Image size 2352x1568, 45° field of view, color fundus photograph:
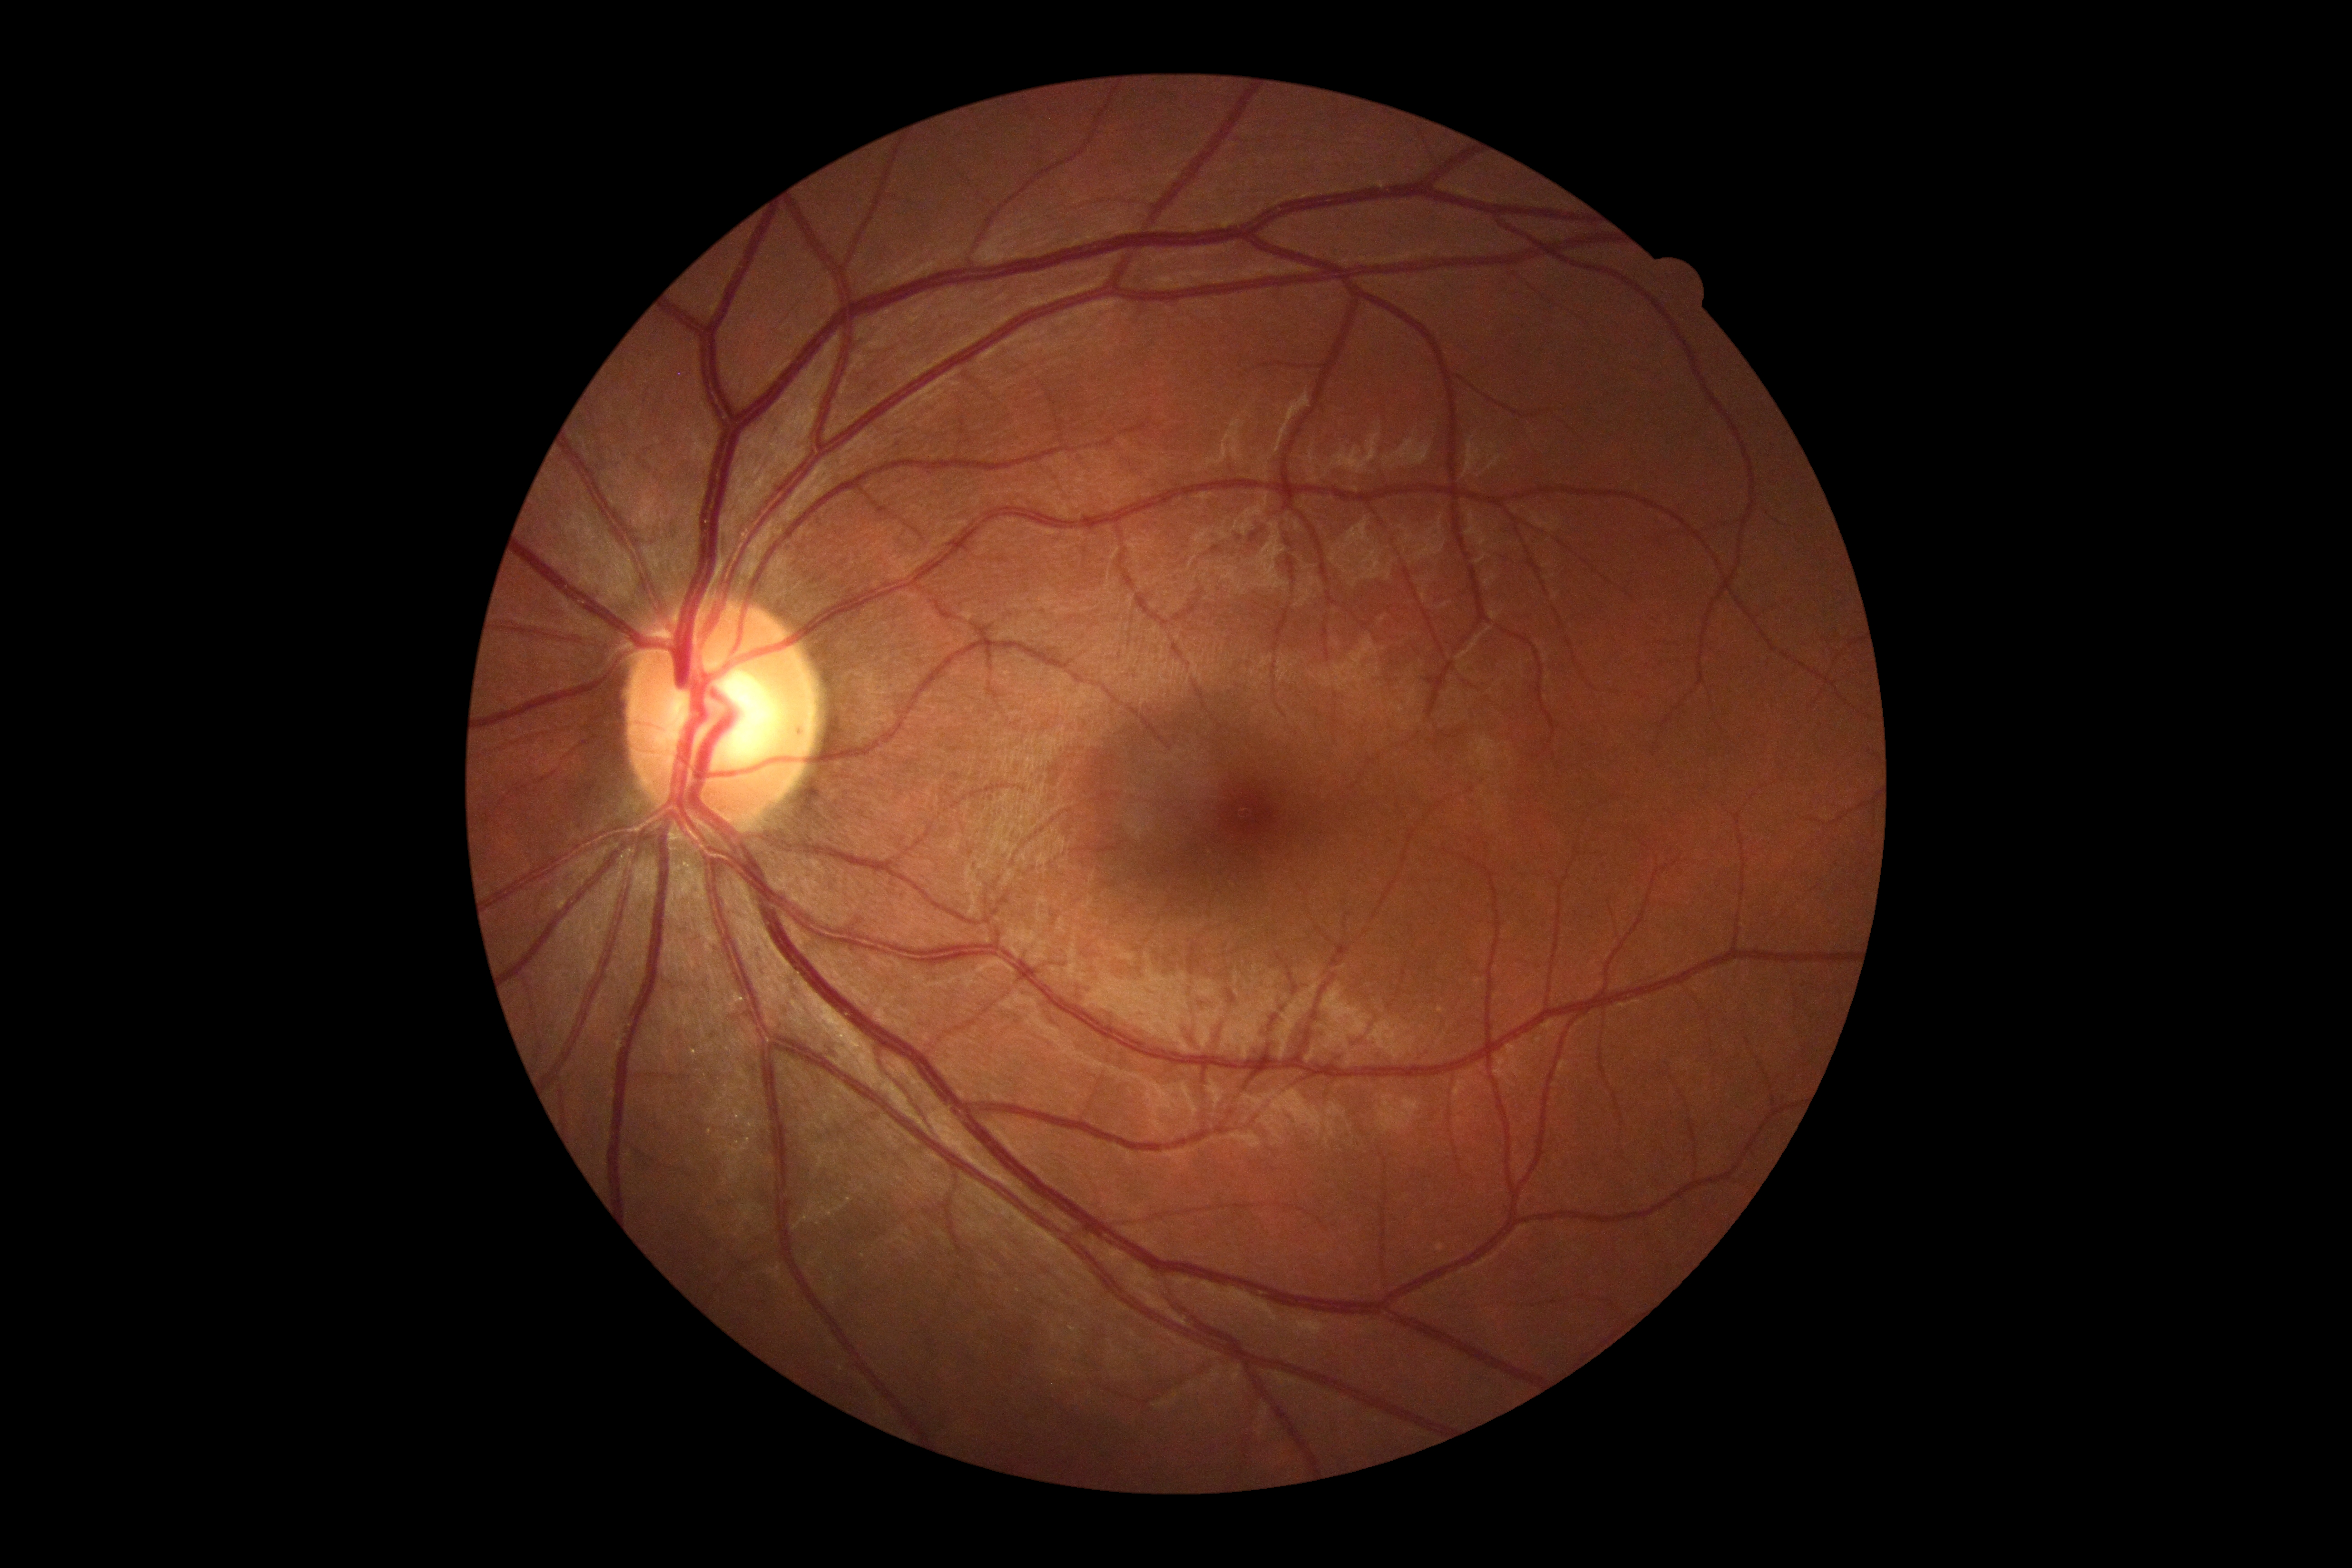 Retinopathy grade: no apparent diabetic retinopathy (0). No diabetic retinal disease findings.